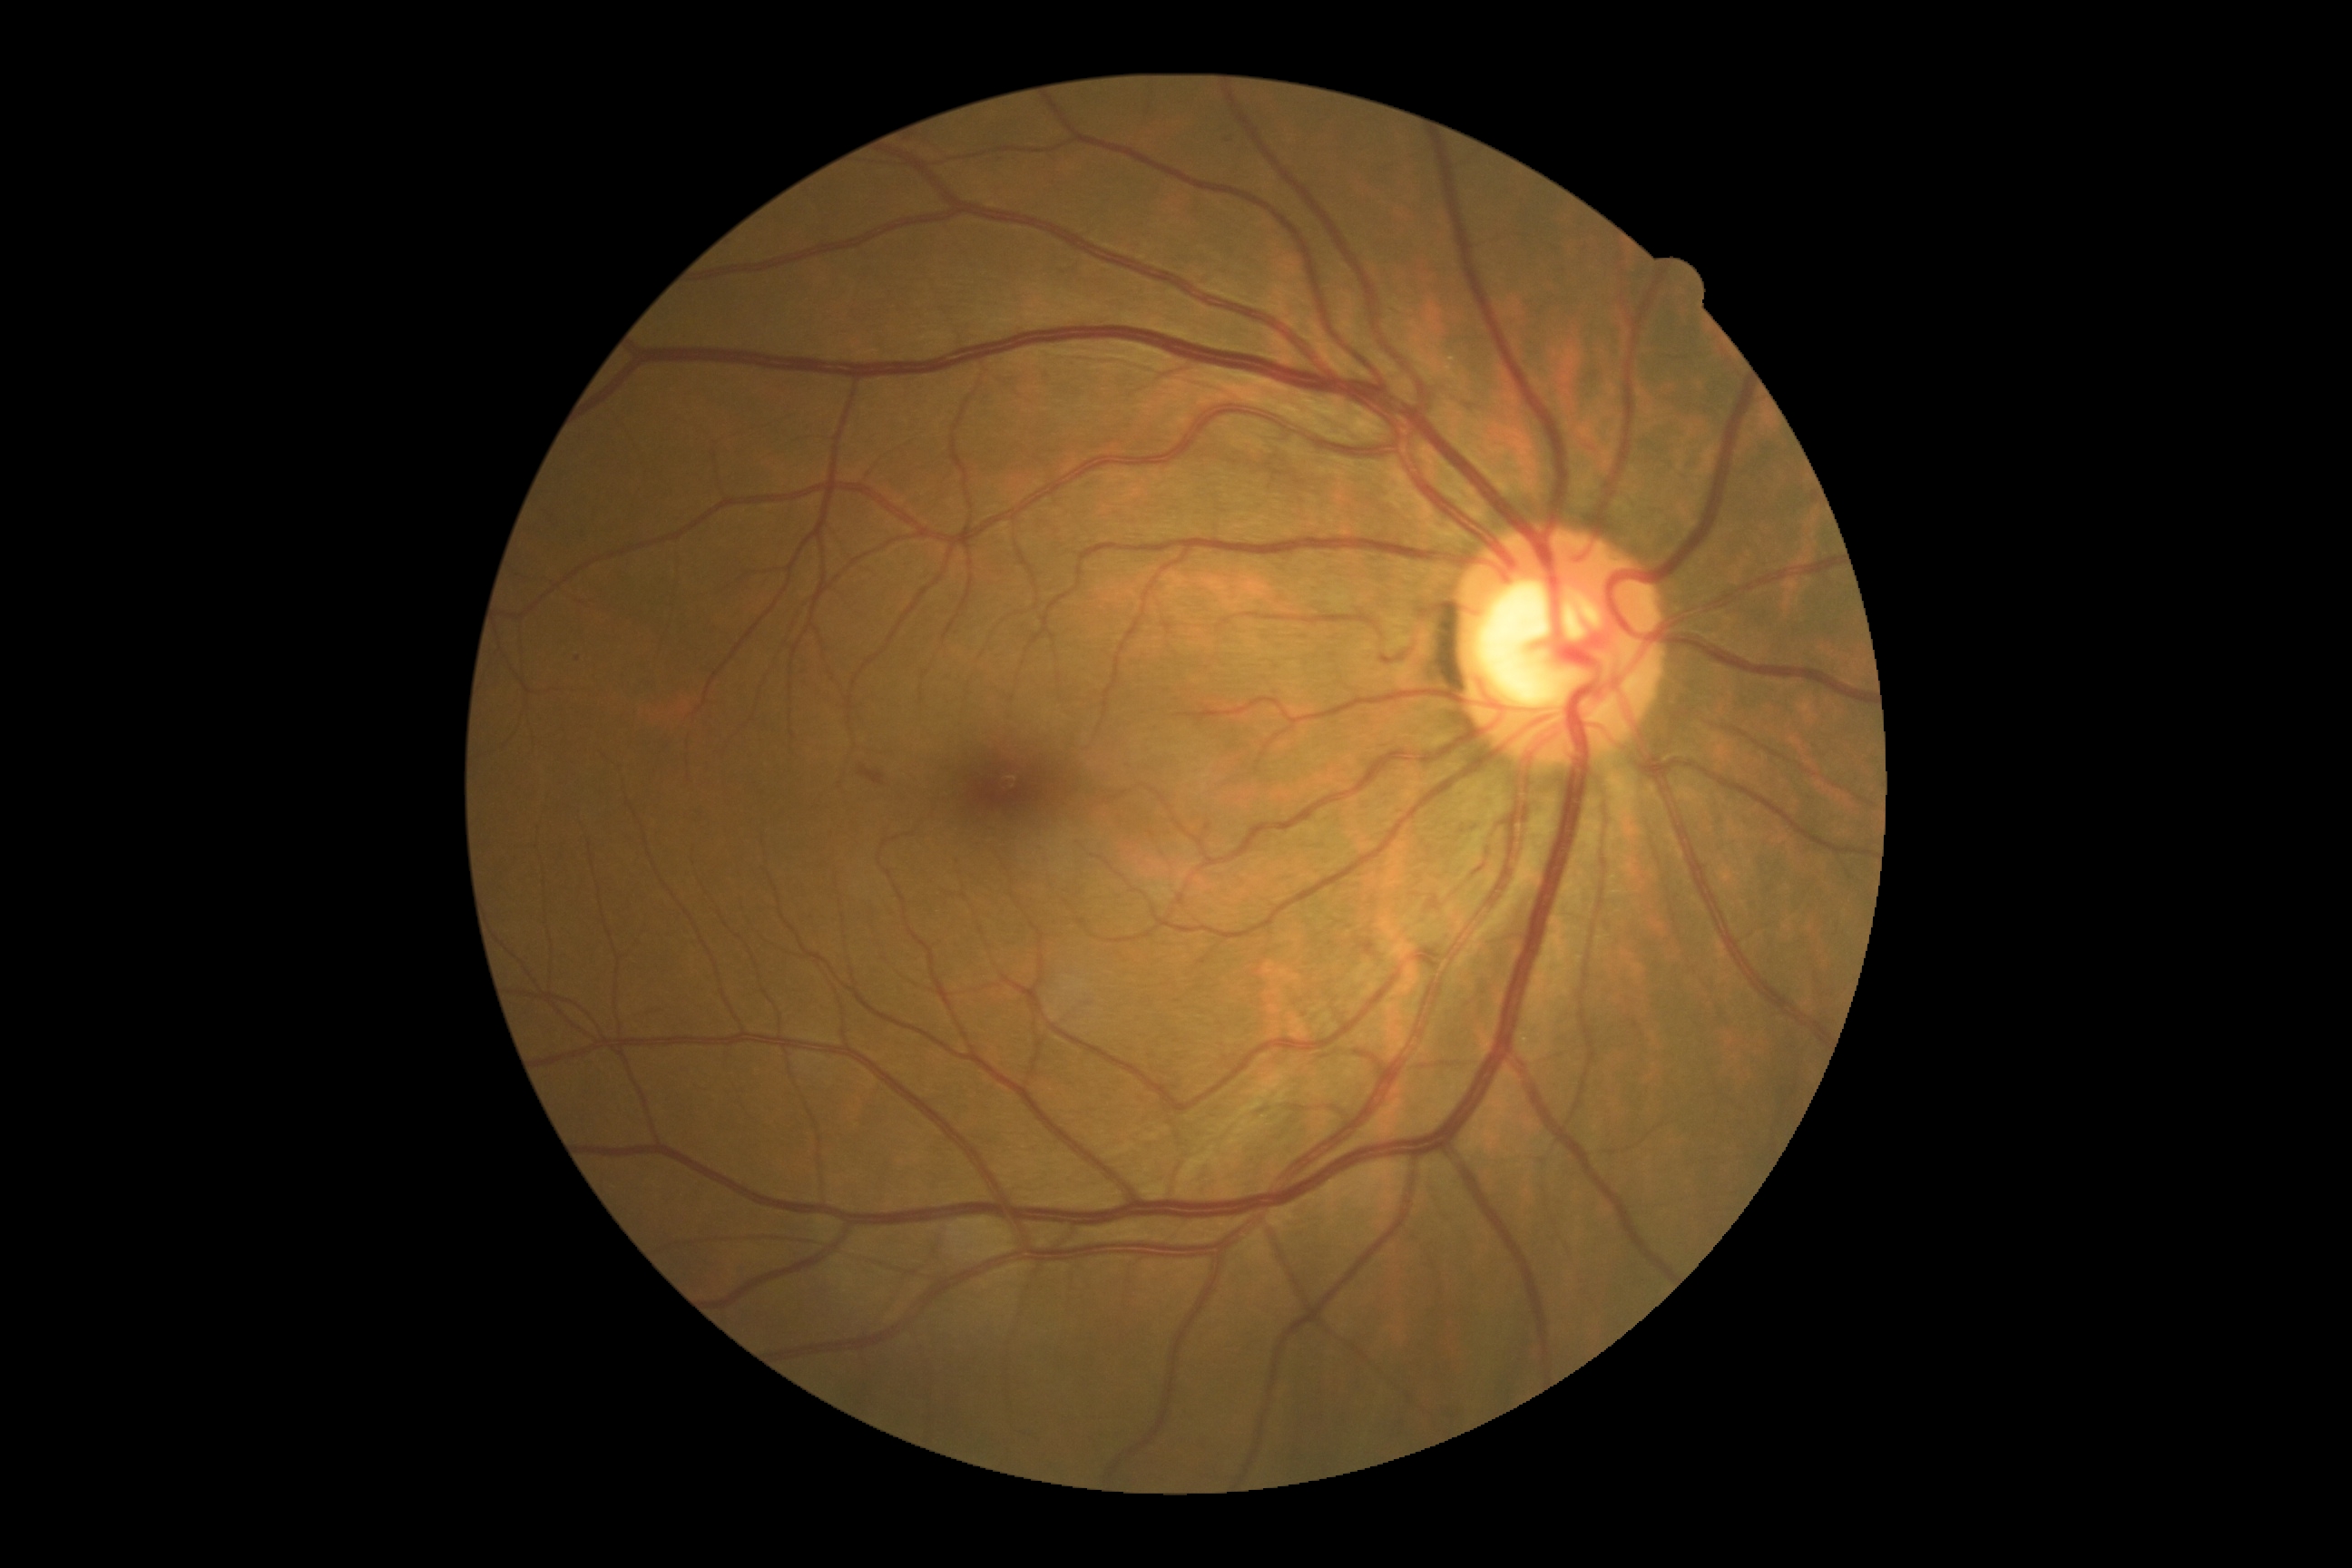
Retinopathy grade: 2/4.